Modified Davis classification: 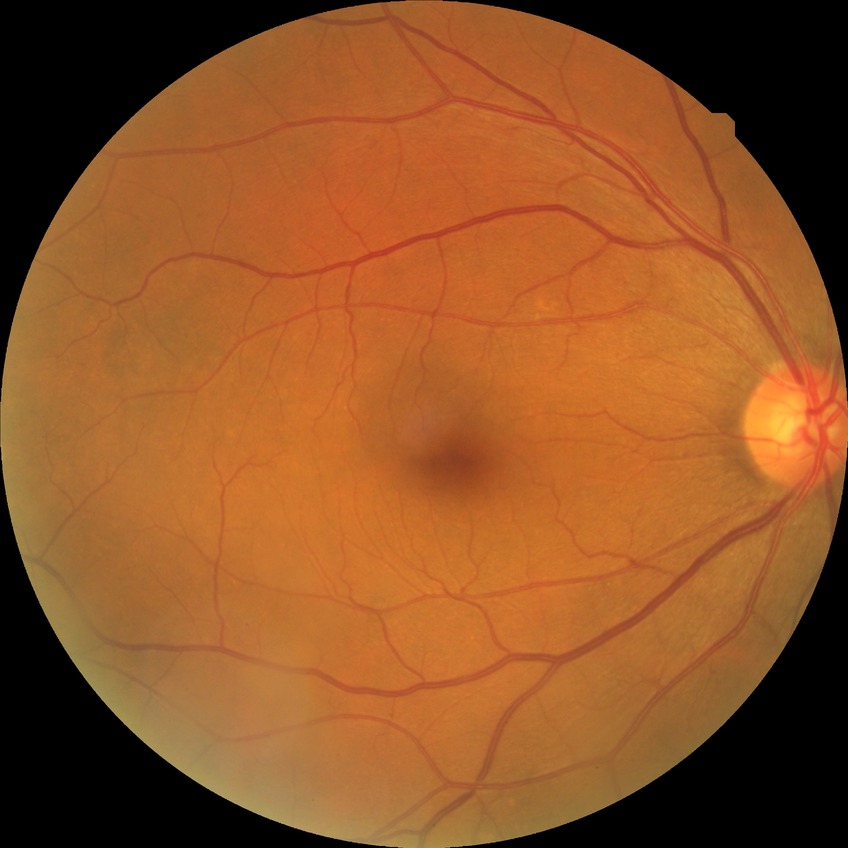 Assessment:
- diabetic retinopathy (DR): SDR (simple diabetic retinopathy)